2212 by 1659 pixels.
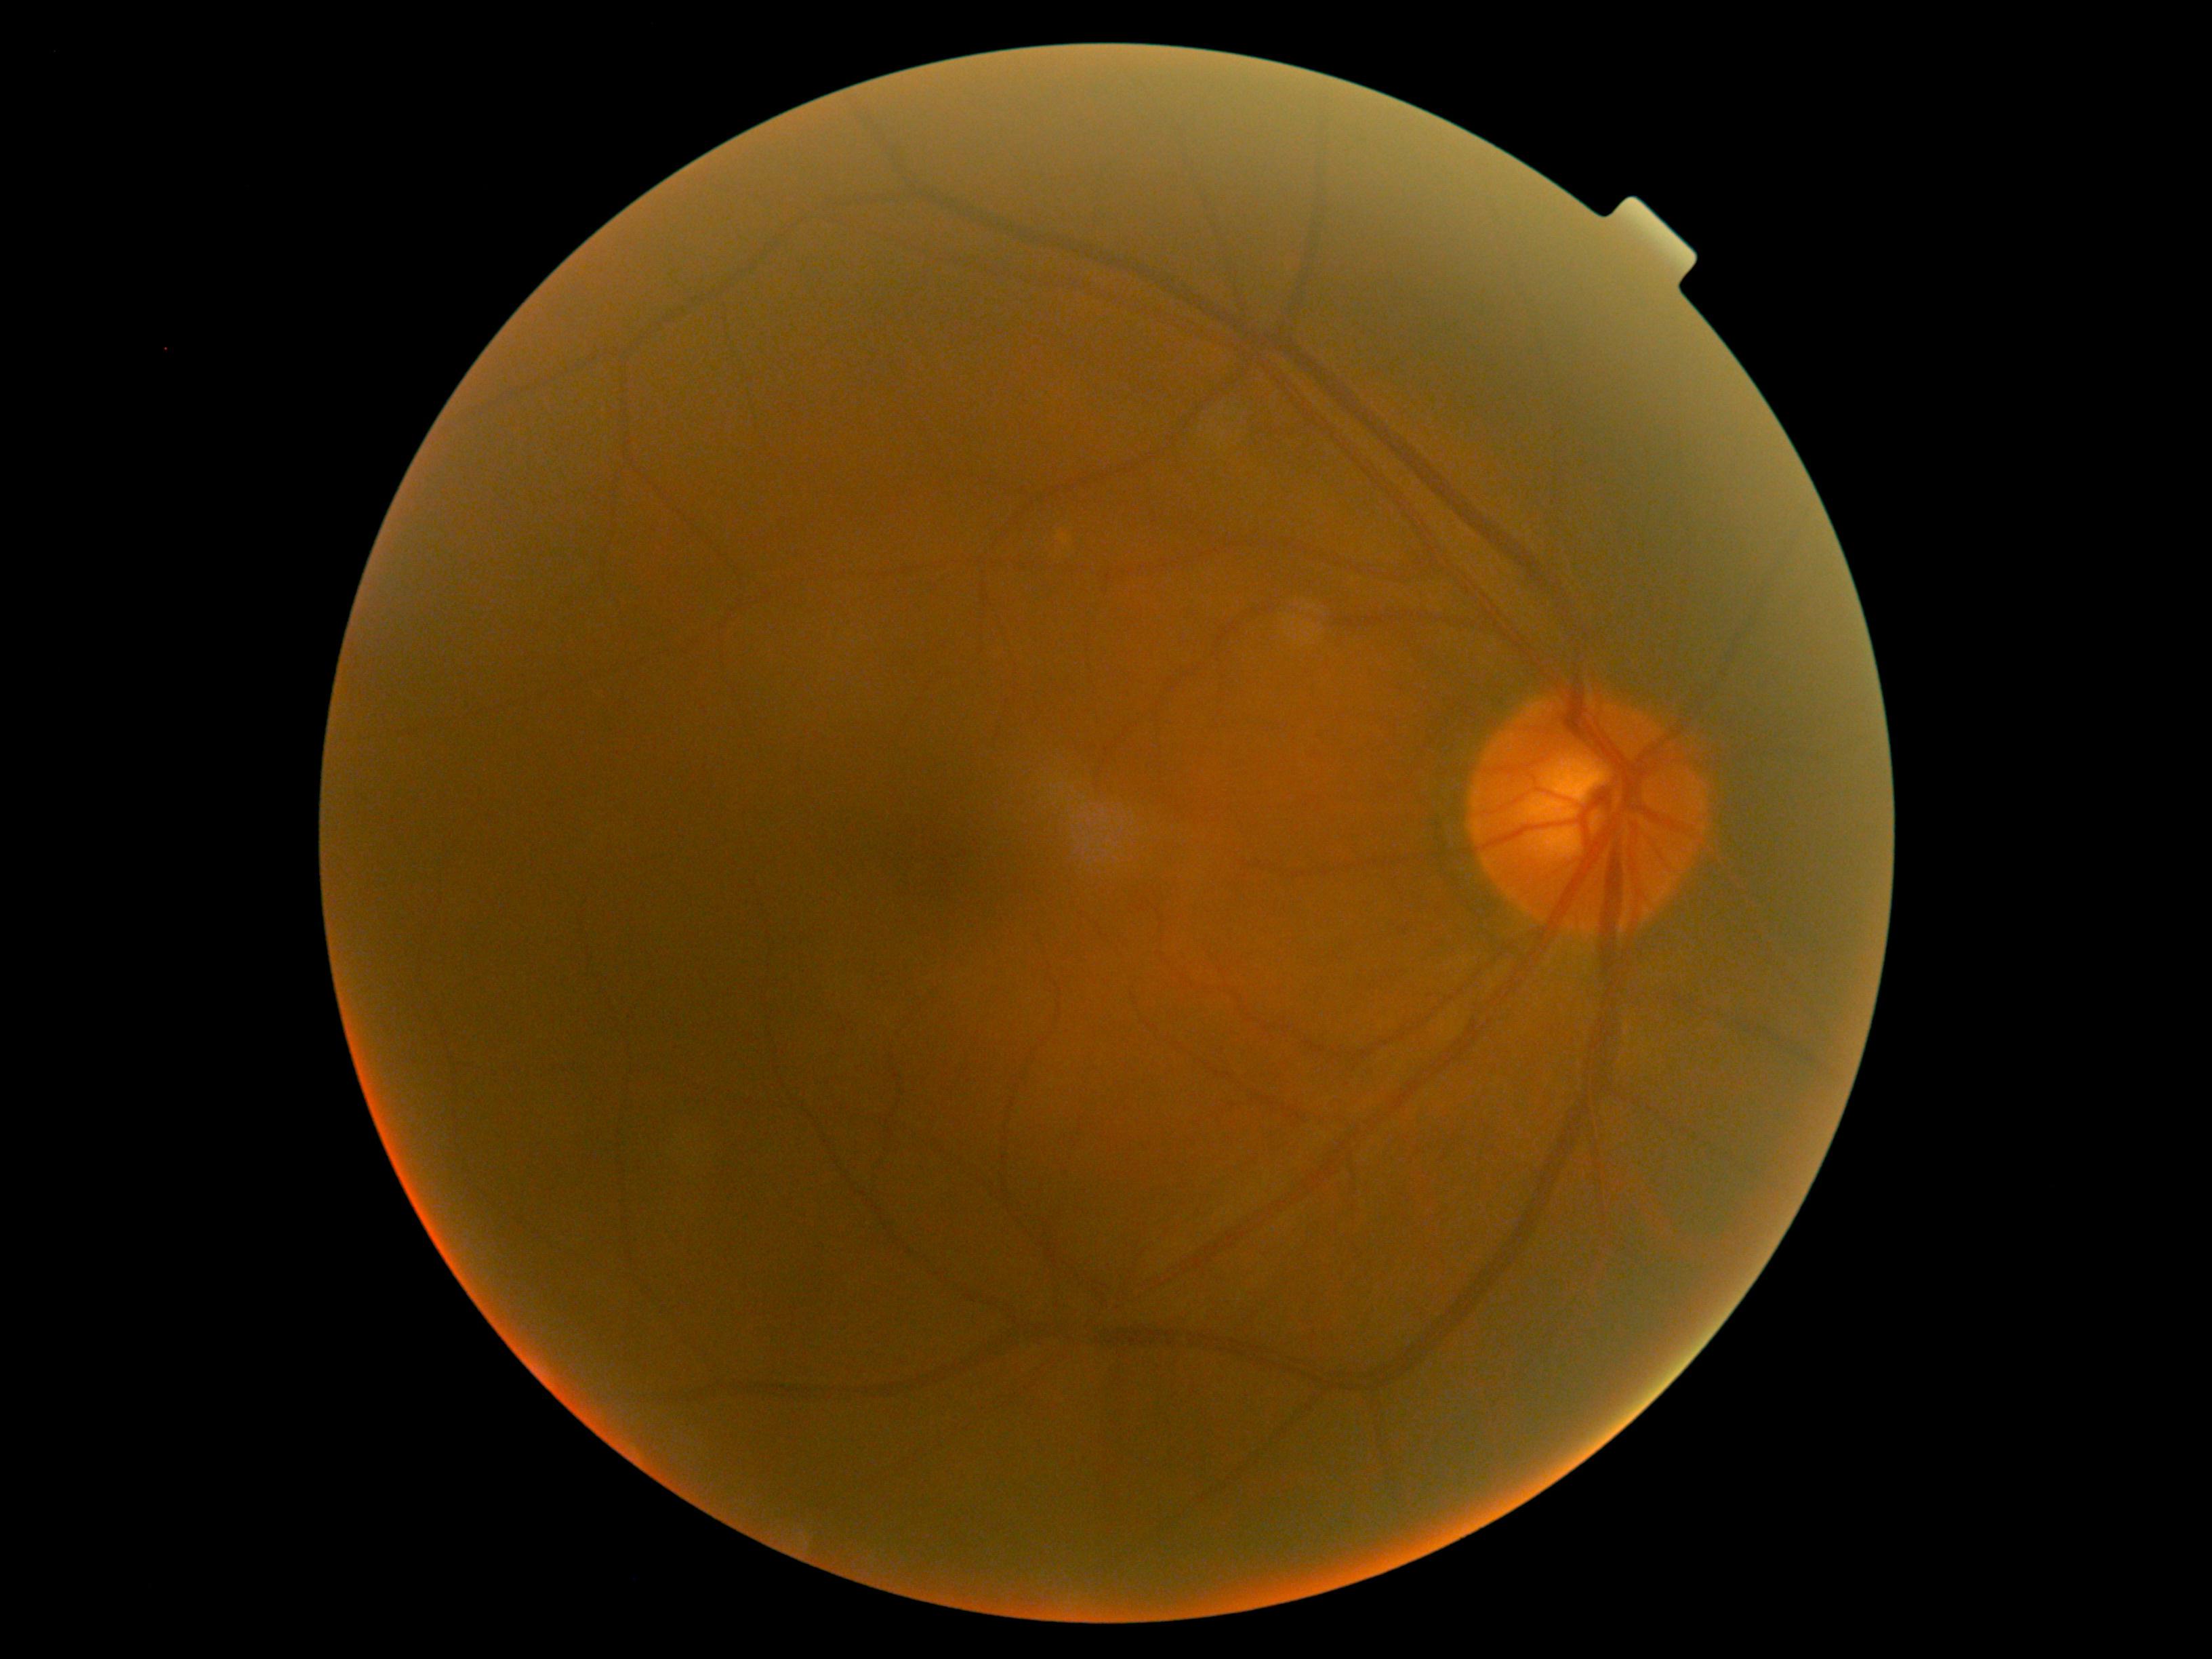 No apparent diabetic retinopathy. DR grade: no apparent diabetic retinopathy (0).